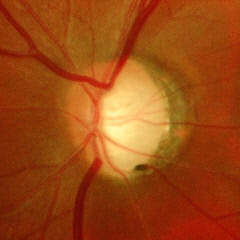

Showing severe glaucomatous damage.